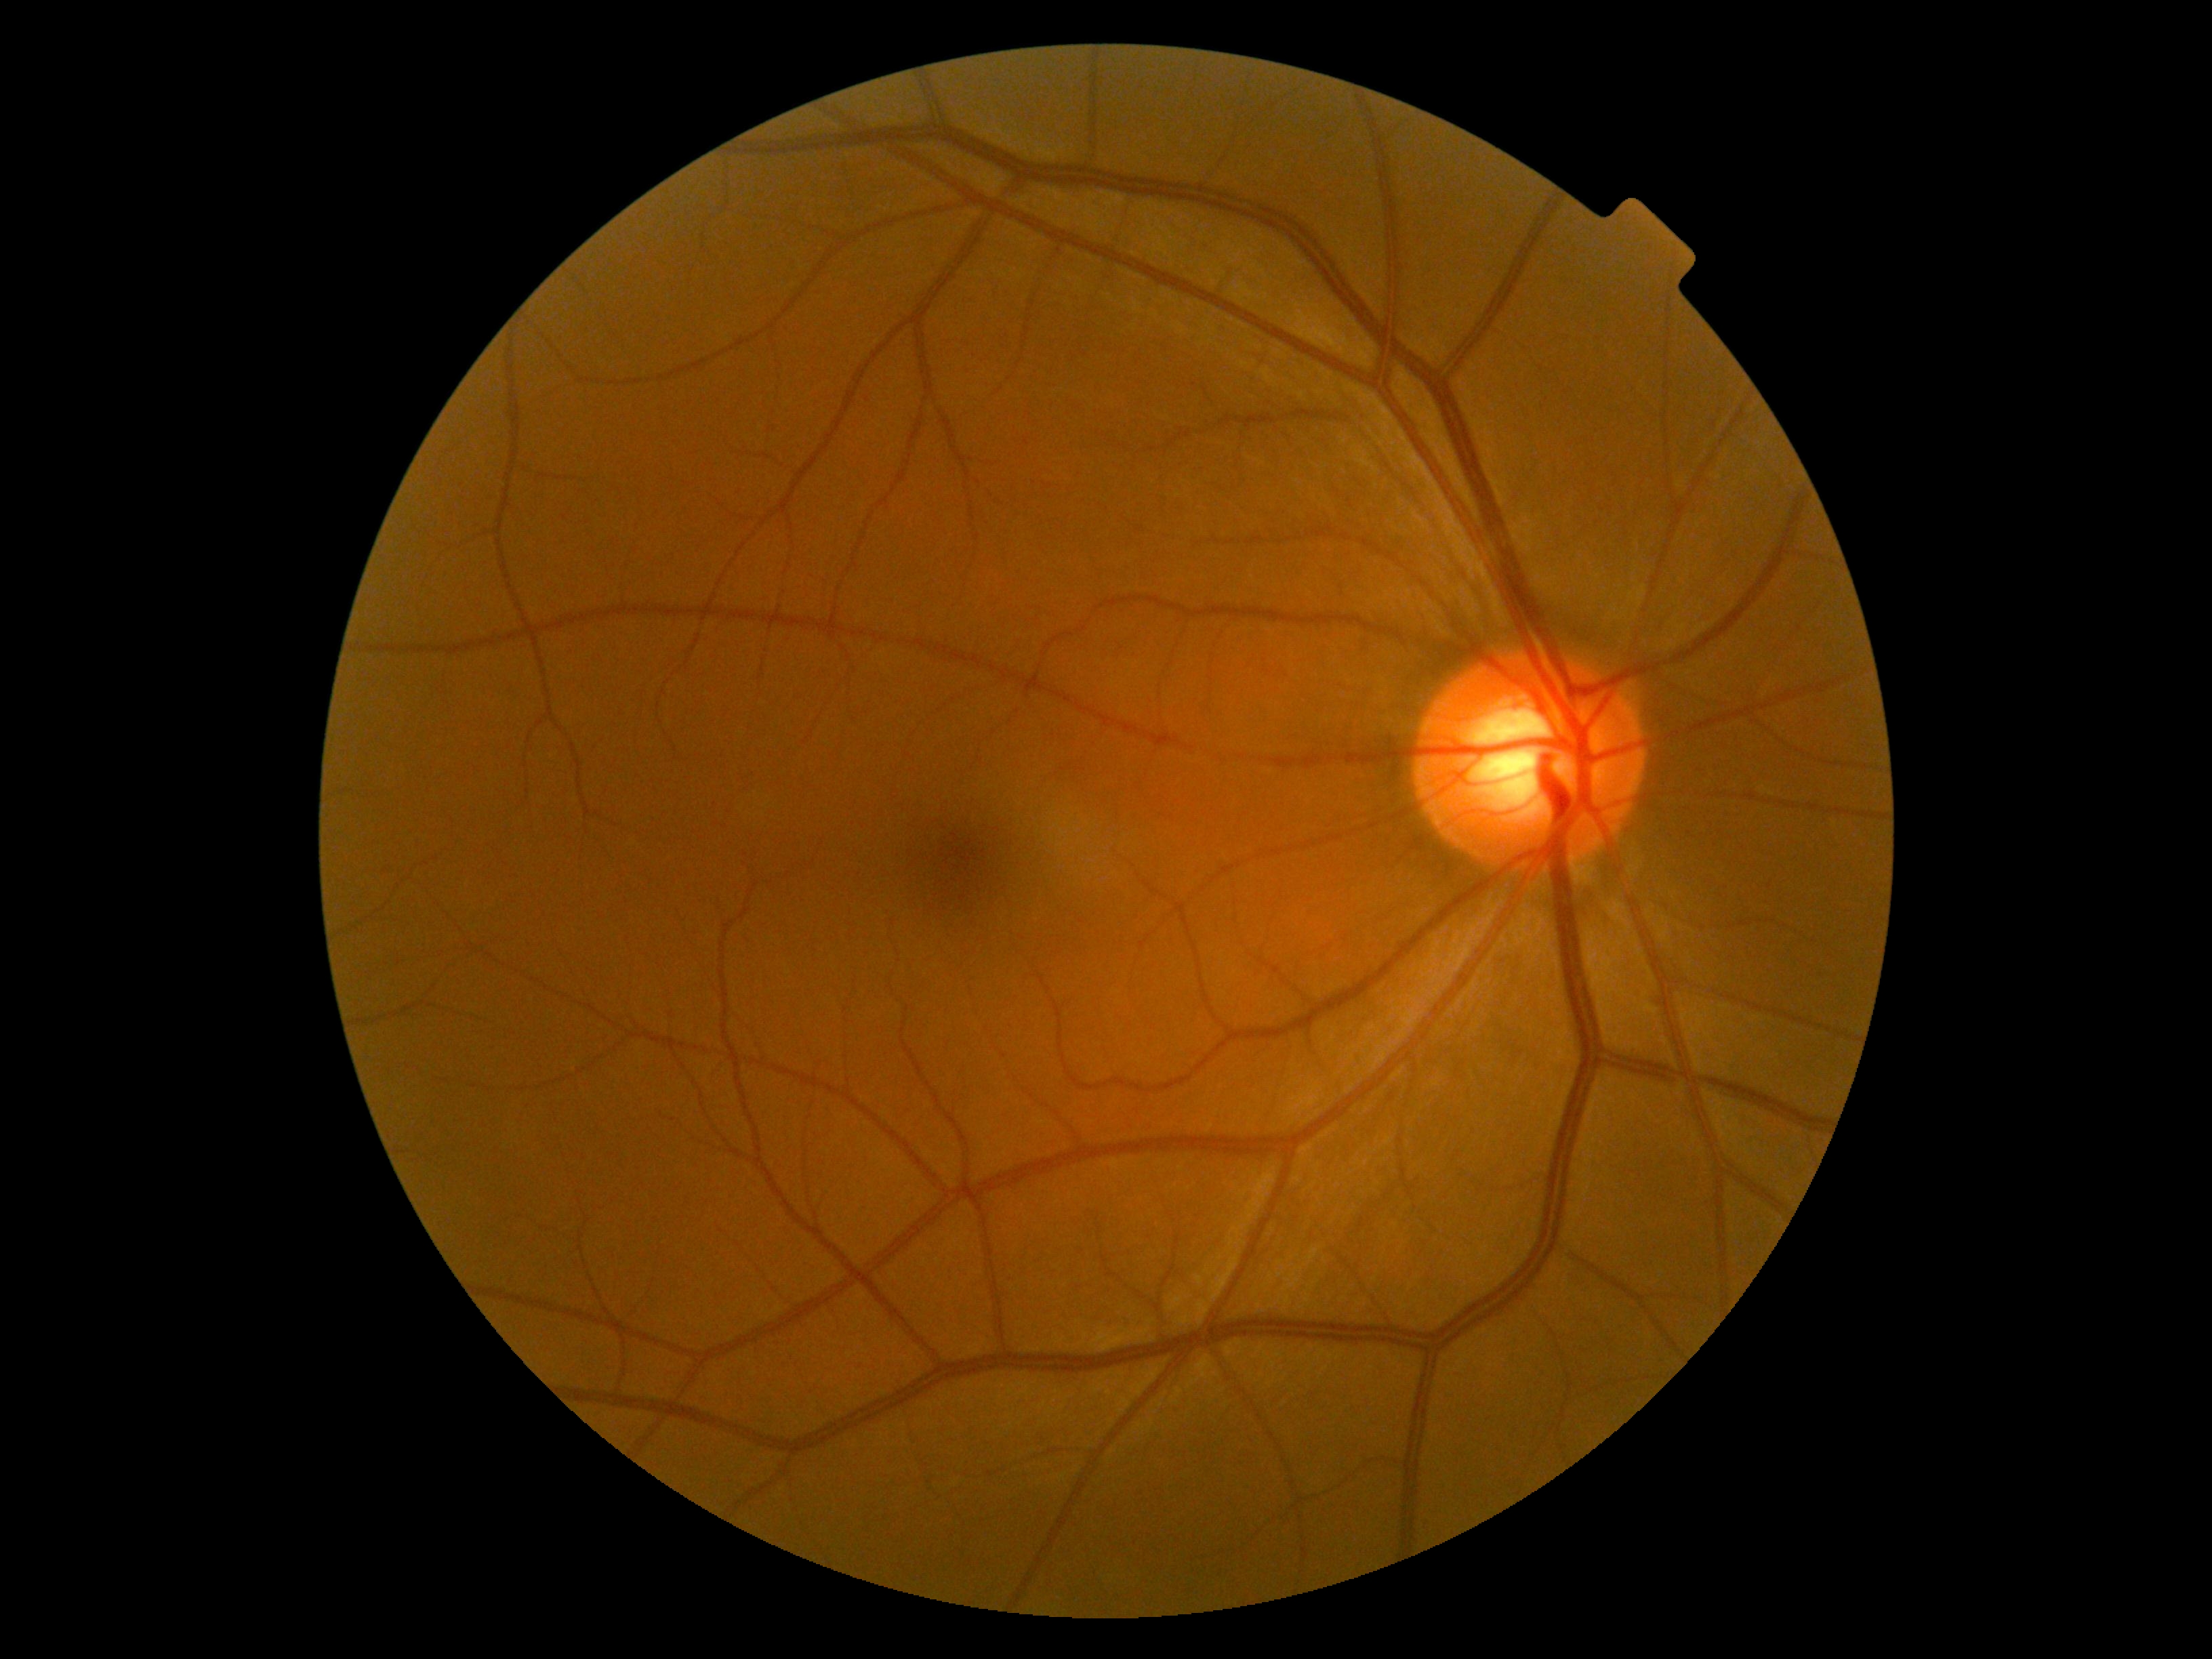
DR: grade 0.